45° field of view; retinal fundus photograph; without pupil dilation; NIDEK AFC-230 fundus camera — 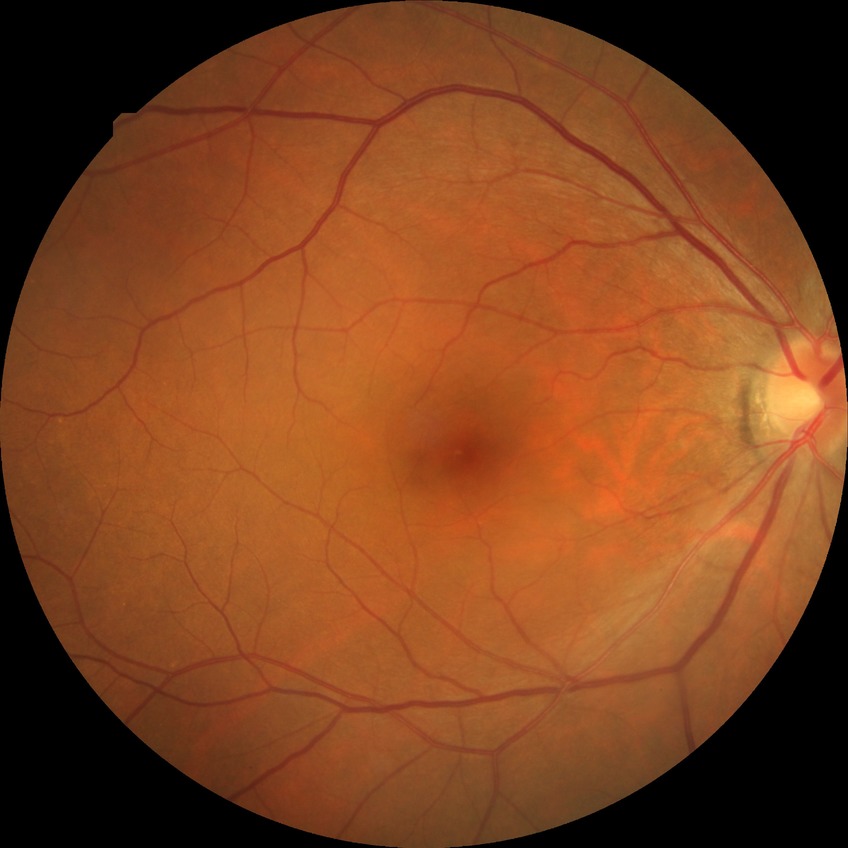

Diabetic retinopathy (DR): no diabetic retinopathy (NDR).